Image size 1440x1080 · pediatric wide-field fundus photograph
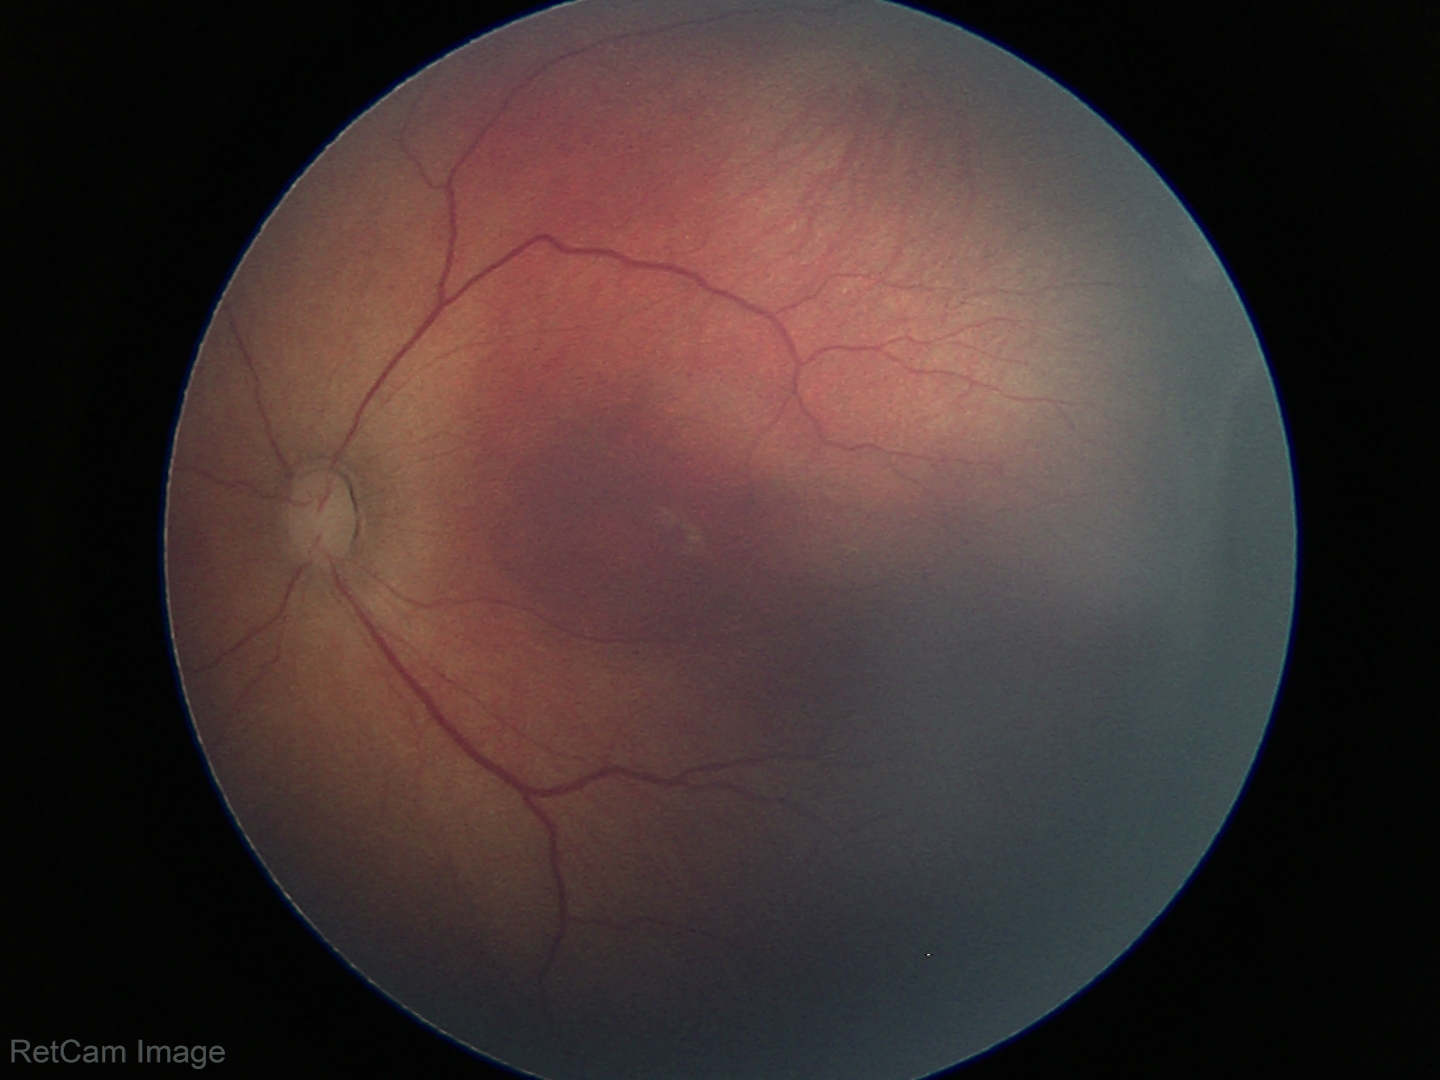

Plus disease absent.
Screening series with ROP stage 3.